45° FOV:
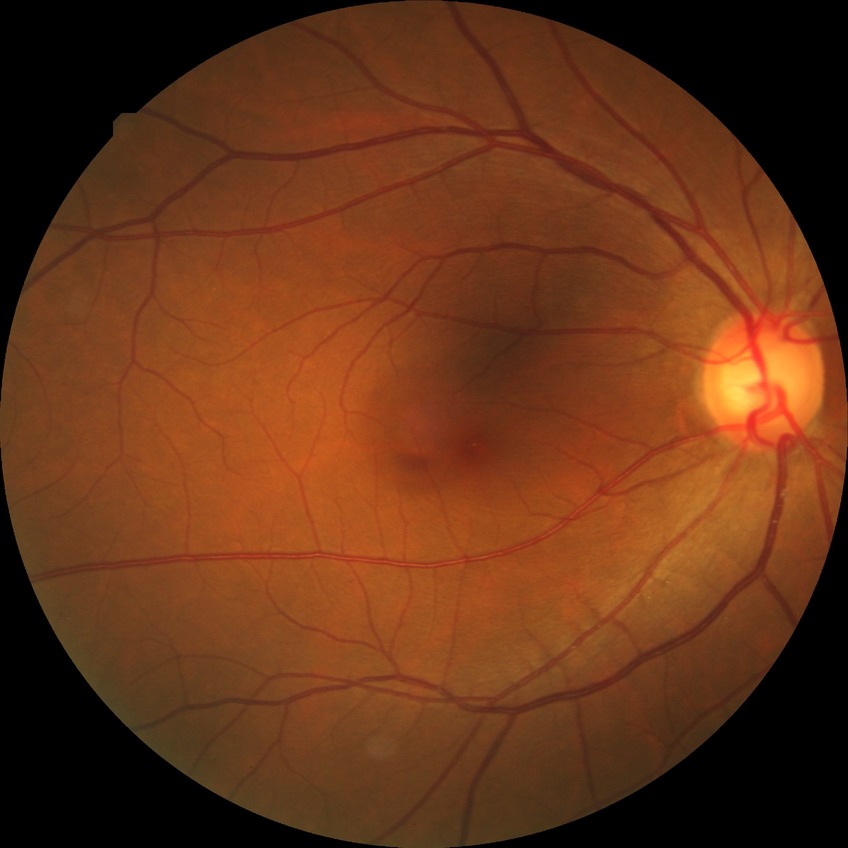

Davis grade is NDR.